Wide-field retinal mosaic image. FOV: 200 degrees: 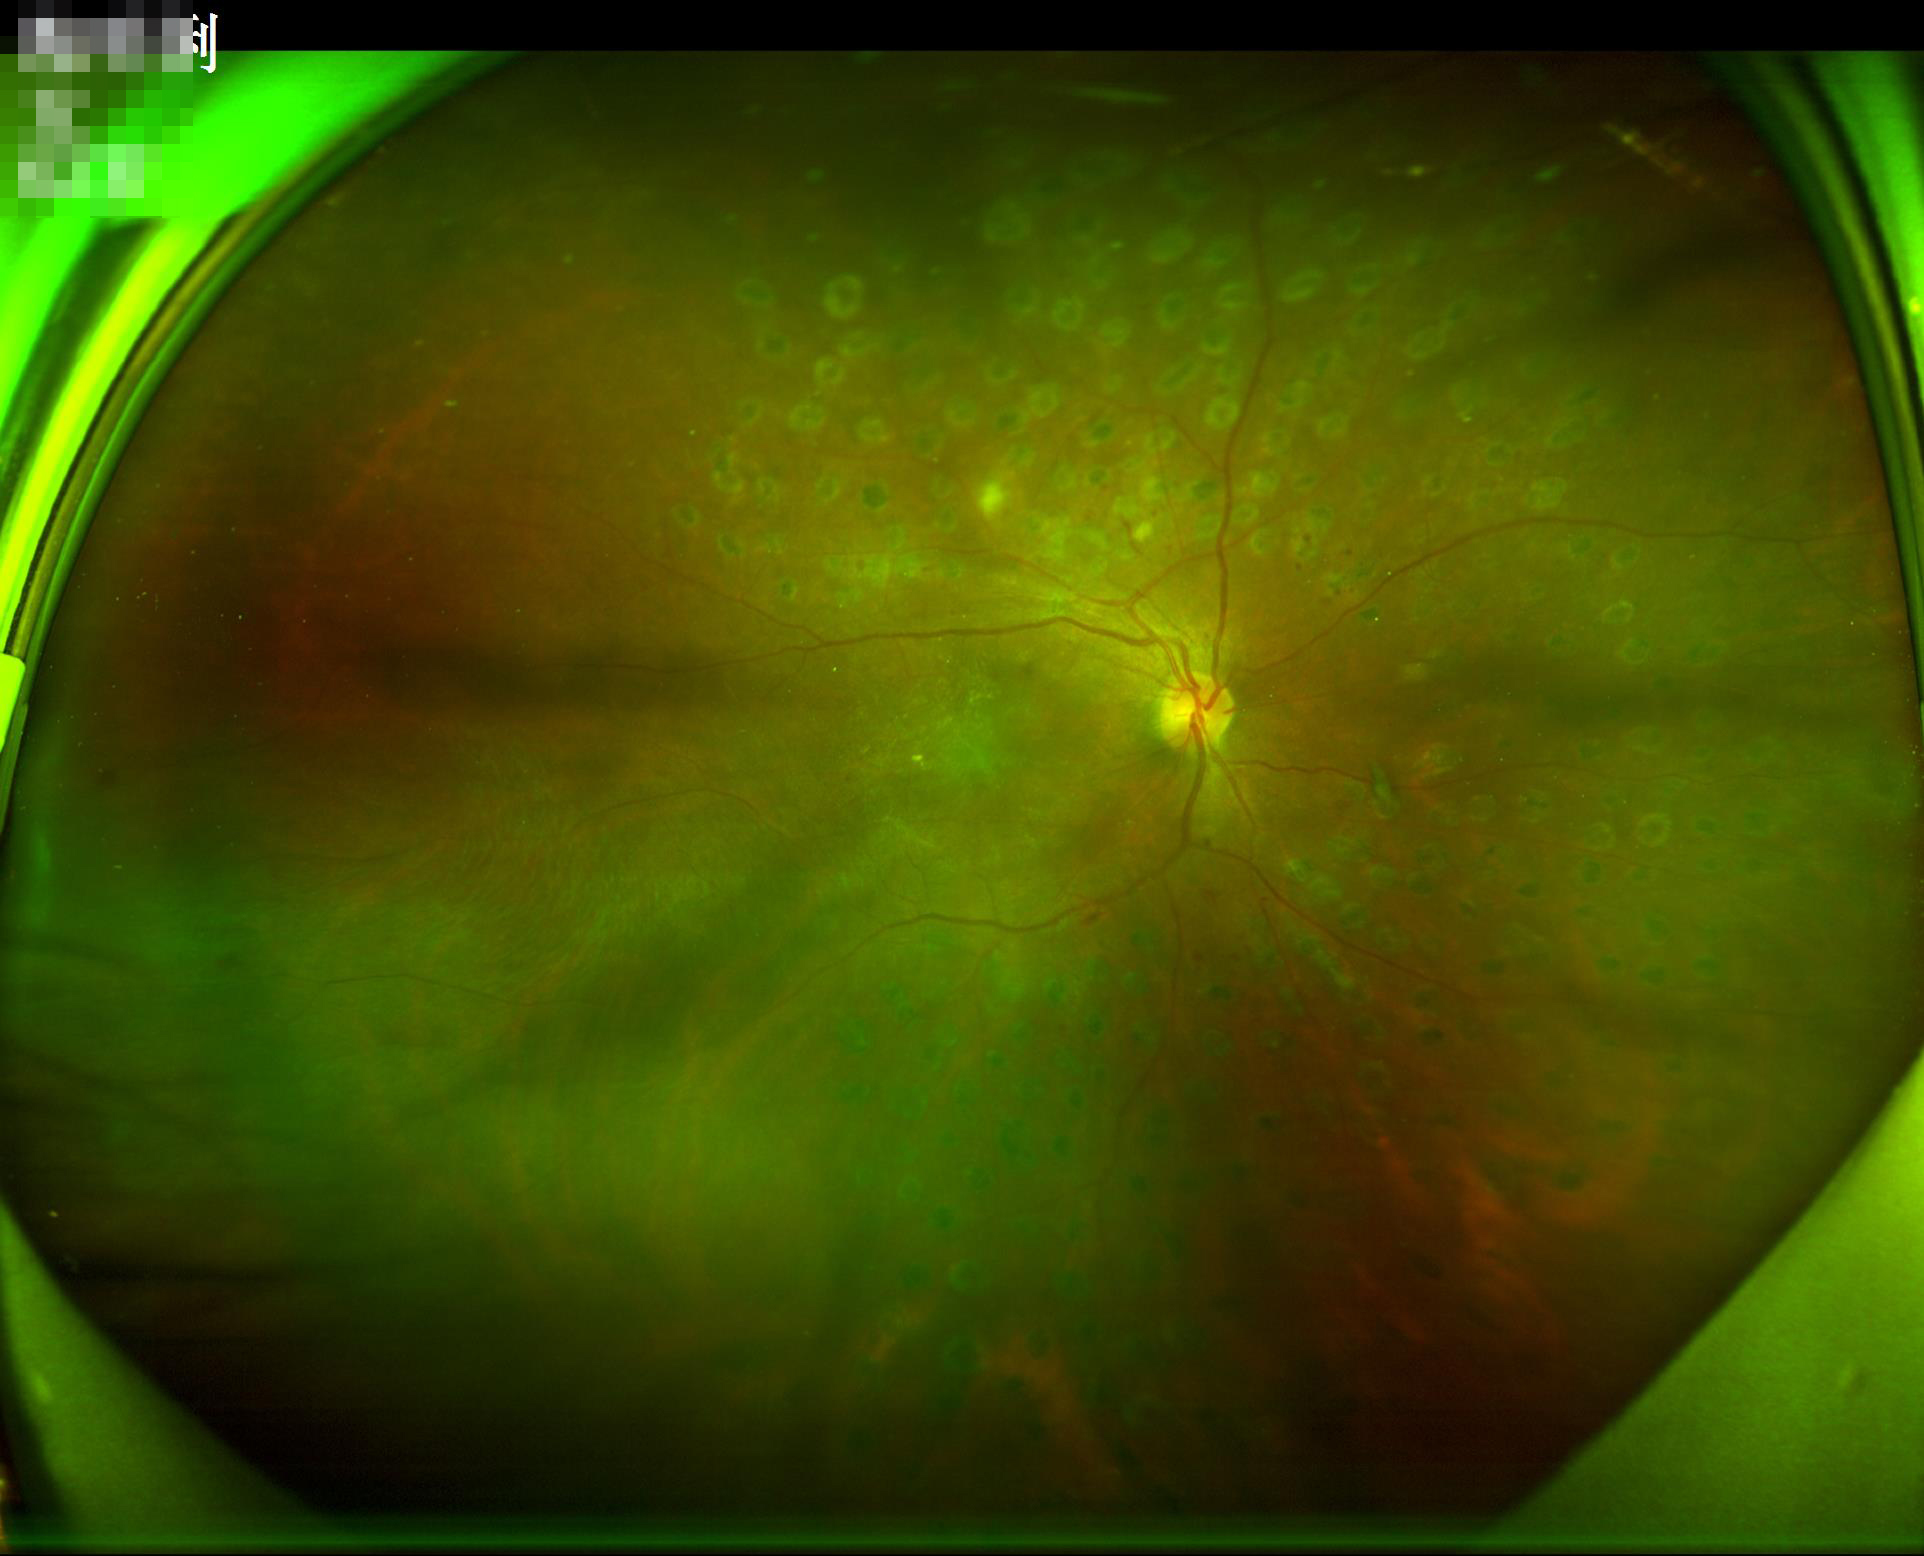

Quality grading: overall: low; illumination/color: uneven.